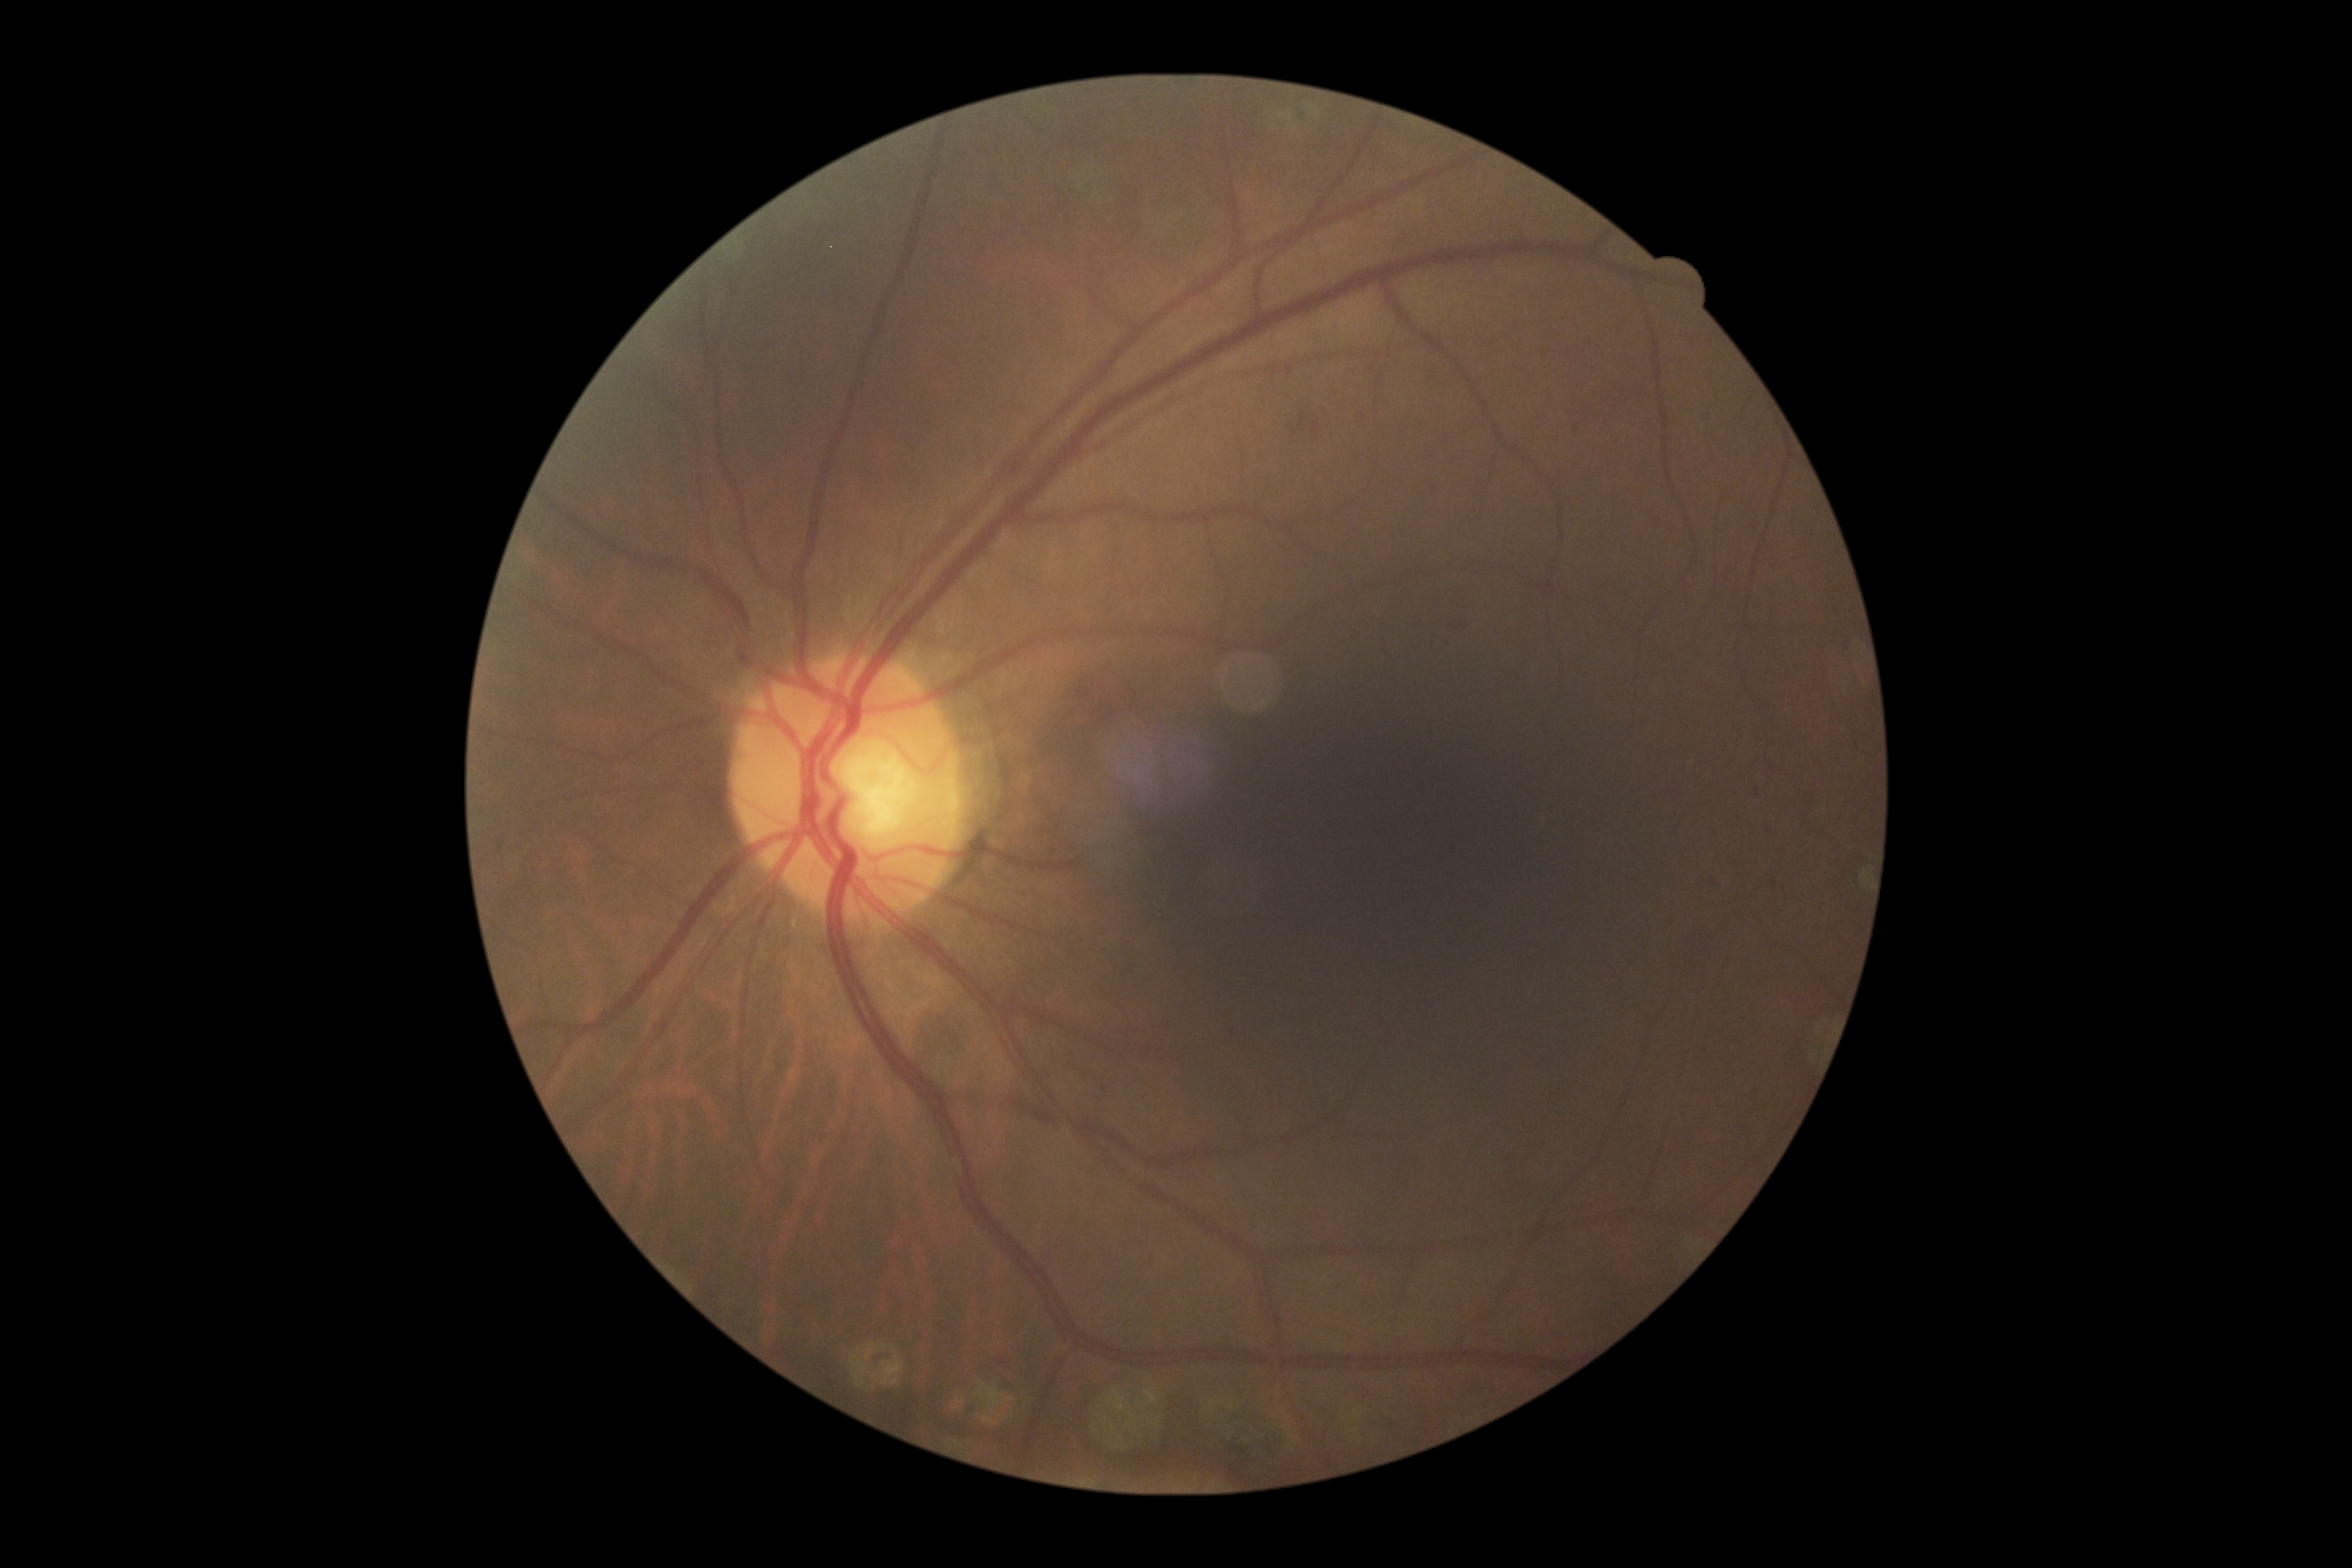

DR grade is 2.